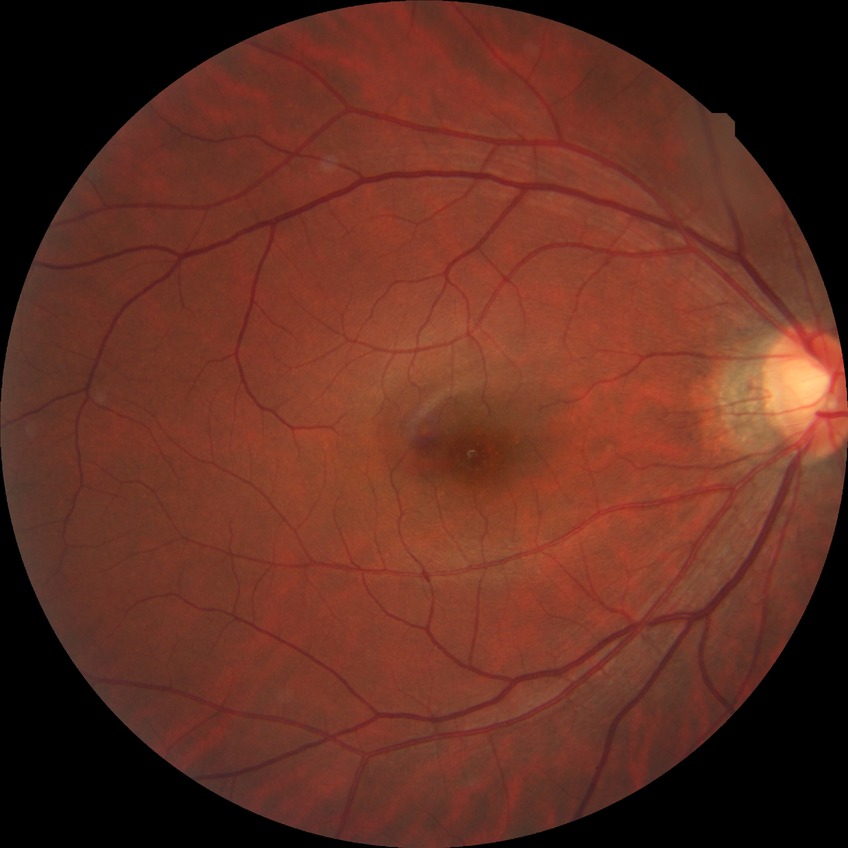

diabetic retinopathy (DR) = no diabetic retinopathy (NDR).